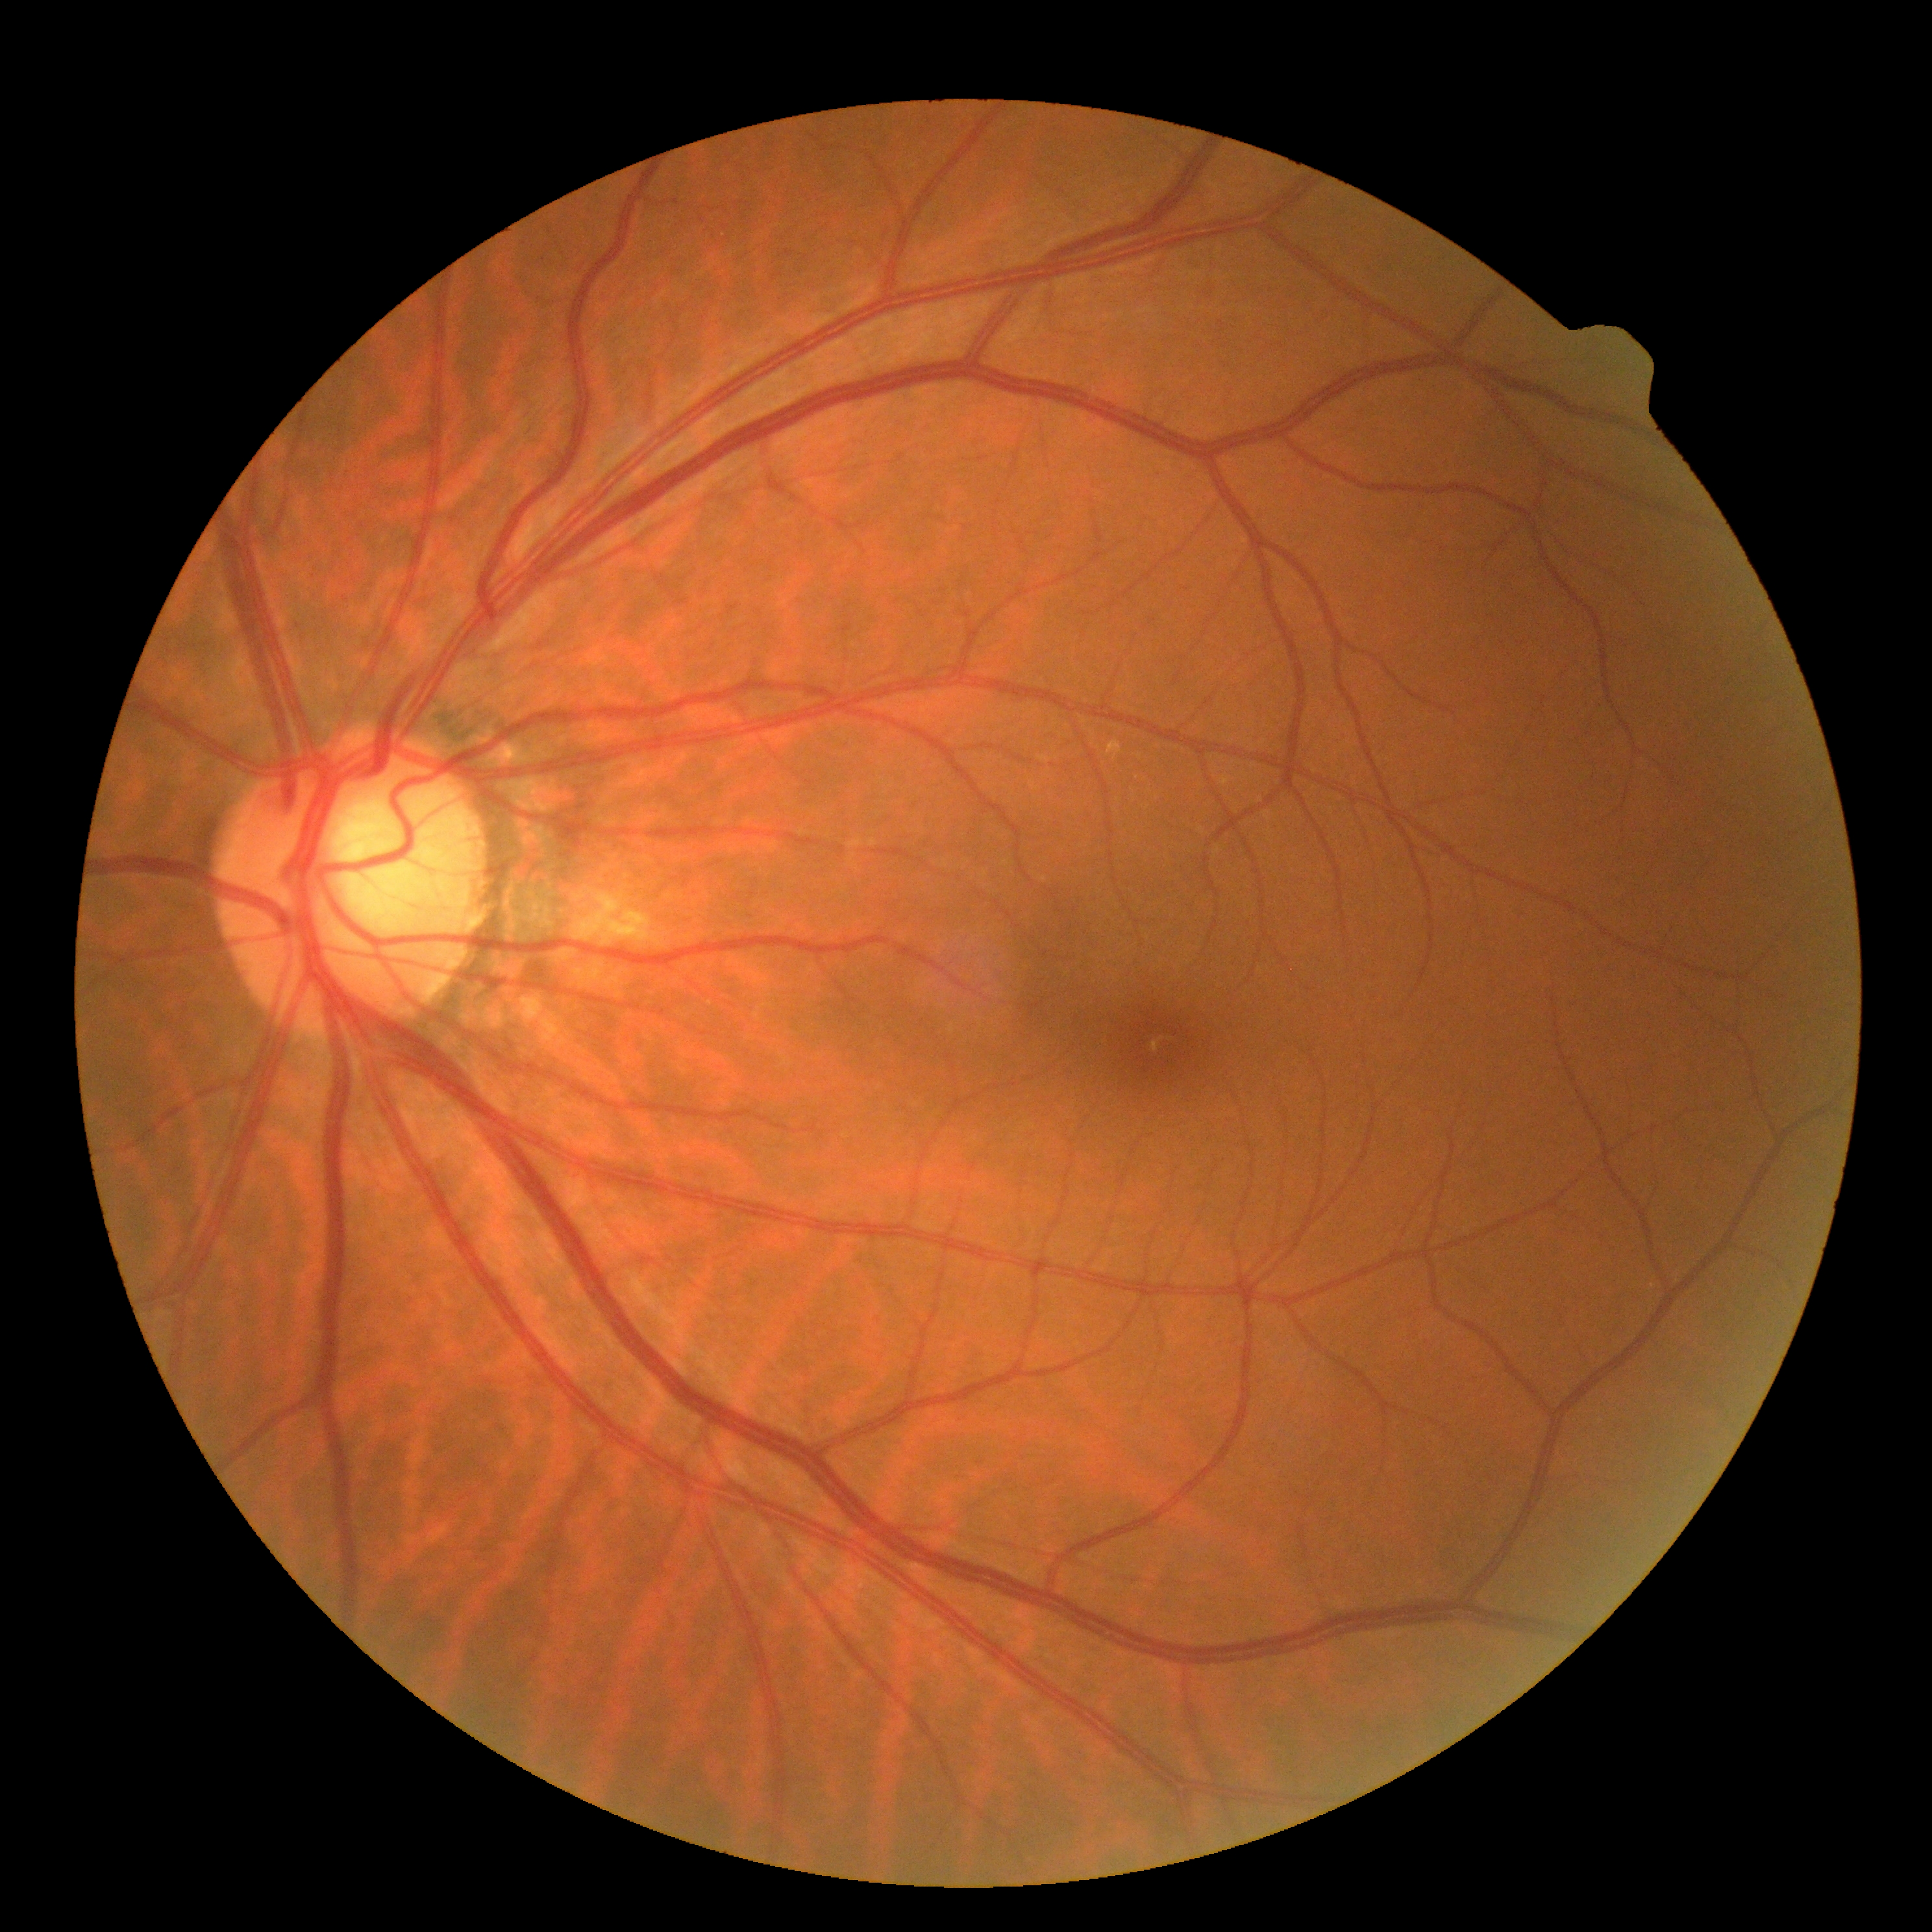
No diabetic retinal disease findings.
DR stage: grade 0.